No pharmacologic dilation · NIDEK AFC-230 fundus camera · 848x848px.
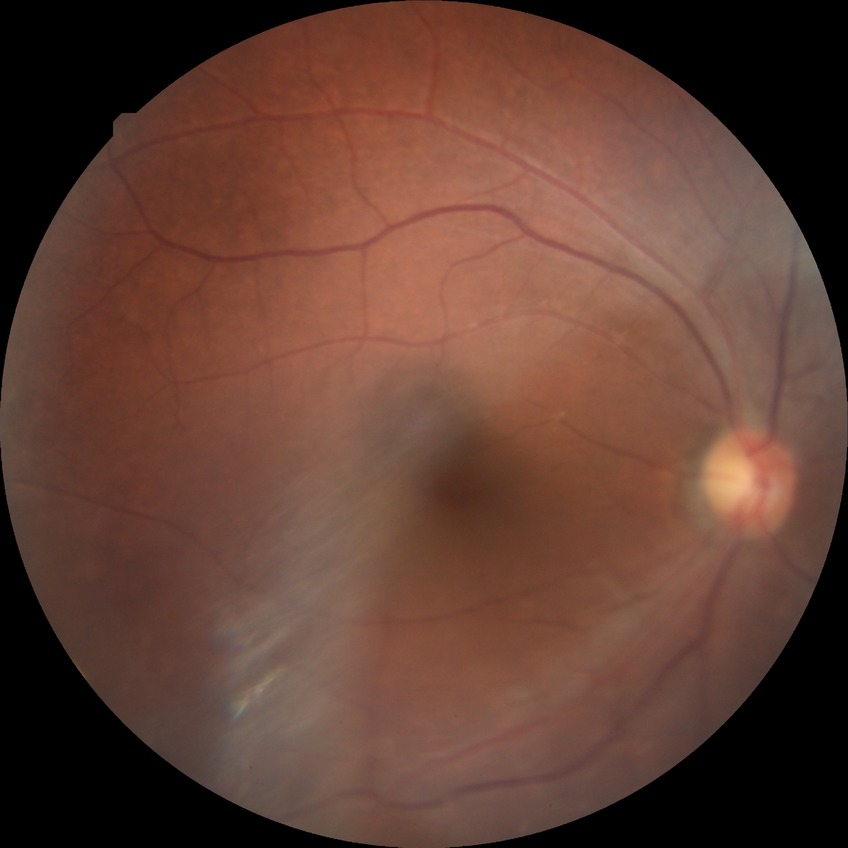

Diabetic retinopathy (DR) is NDR (no diabetic retinopathy).